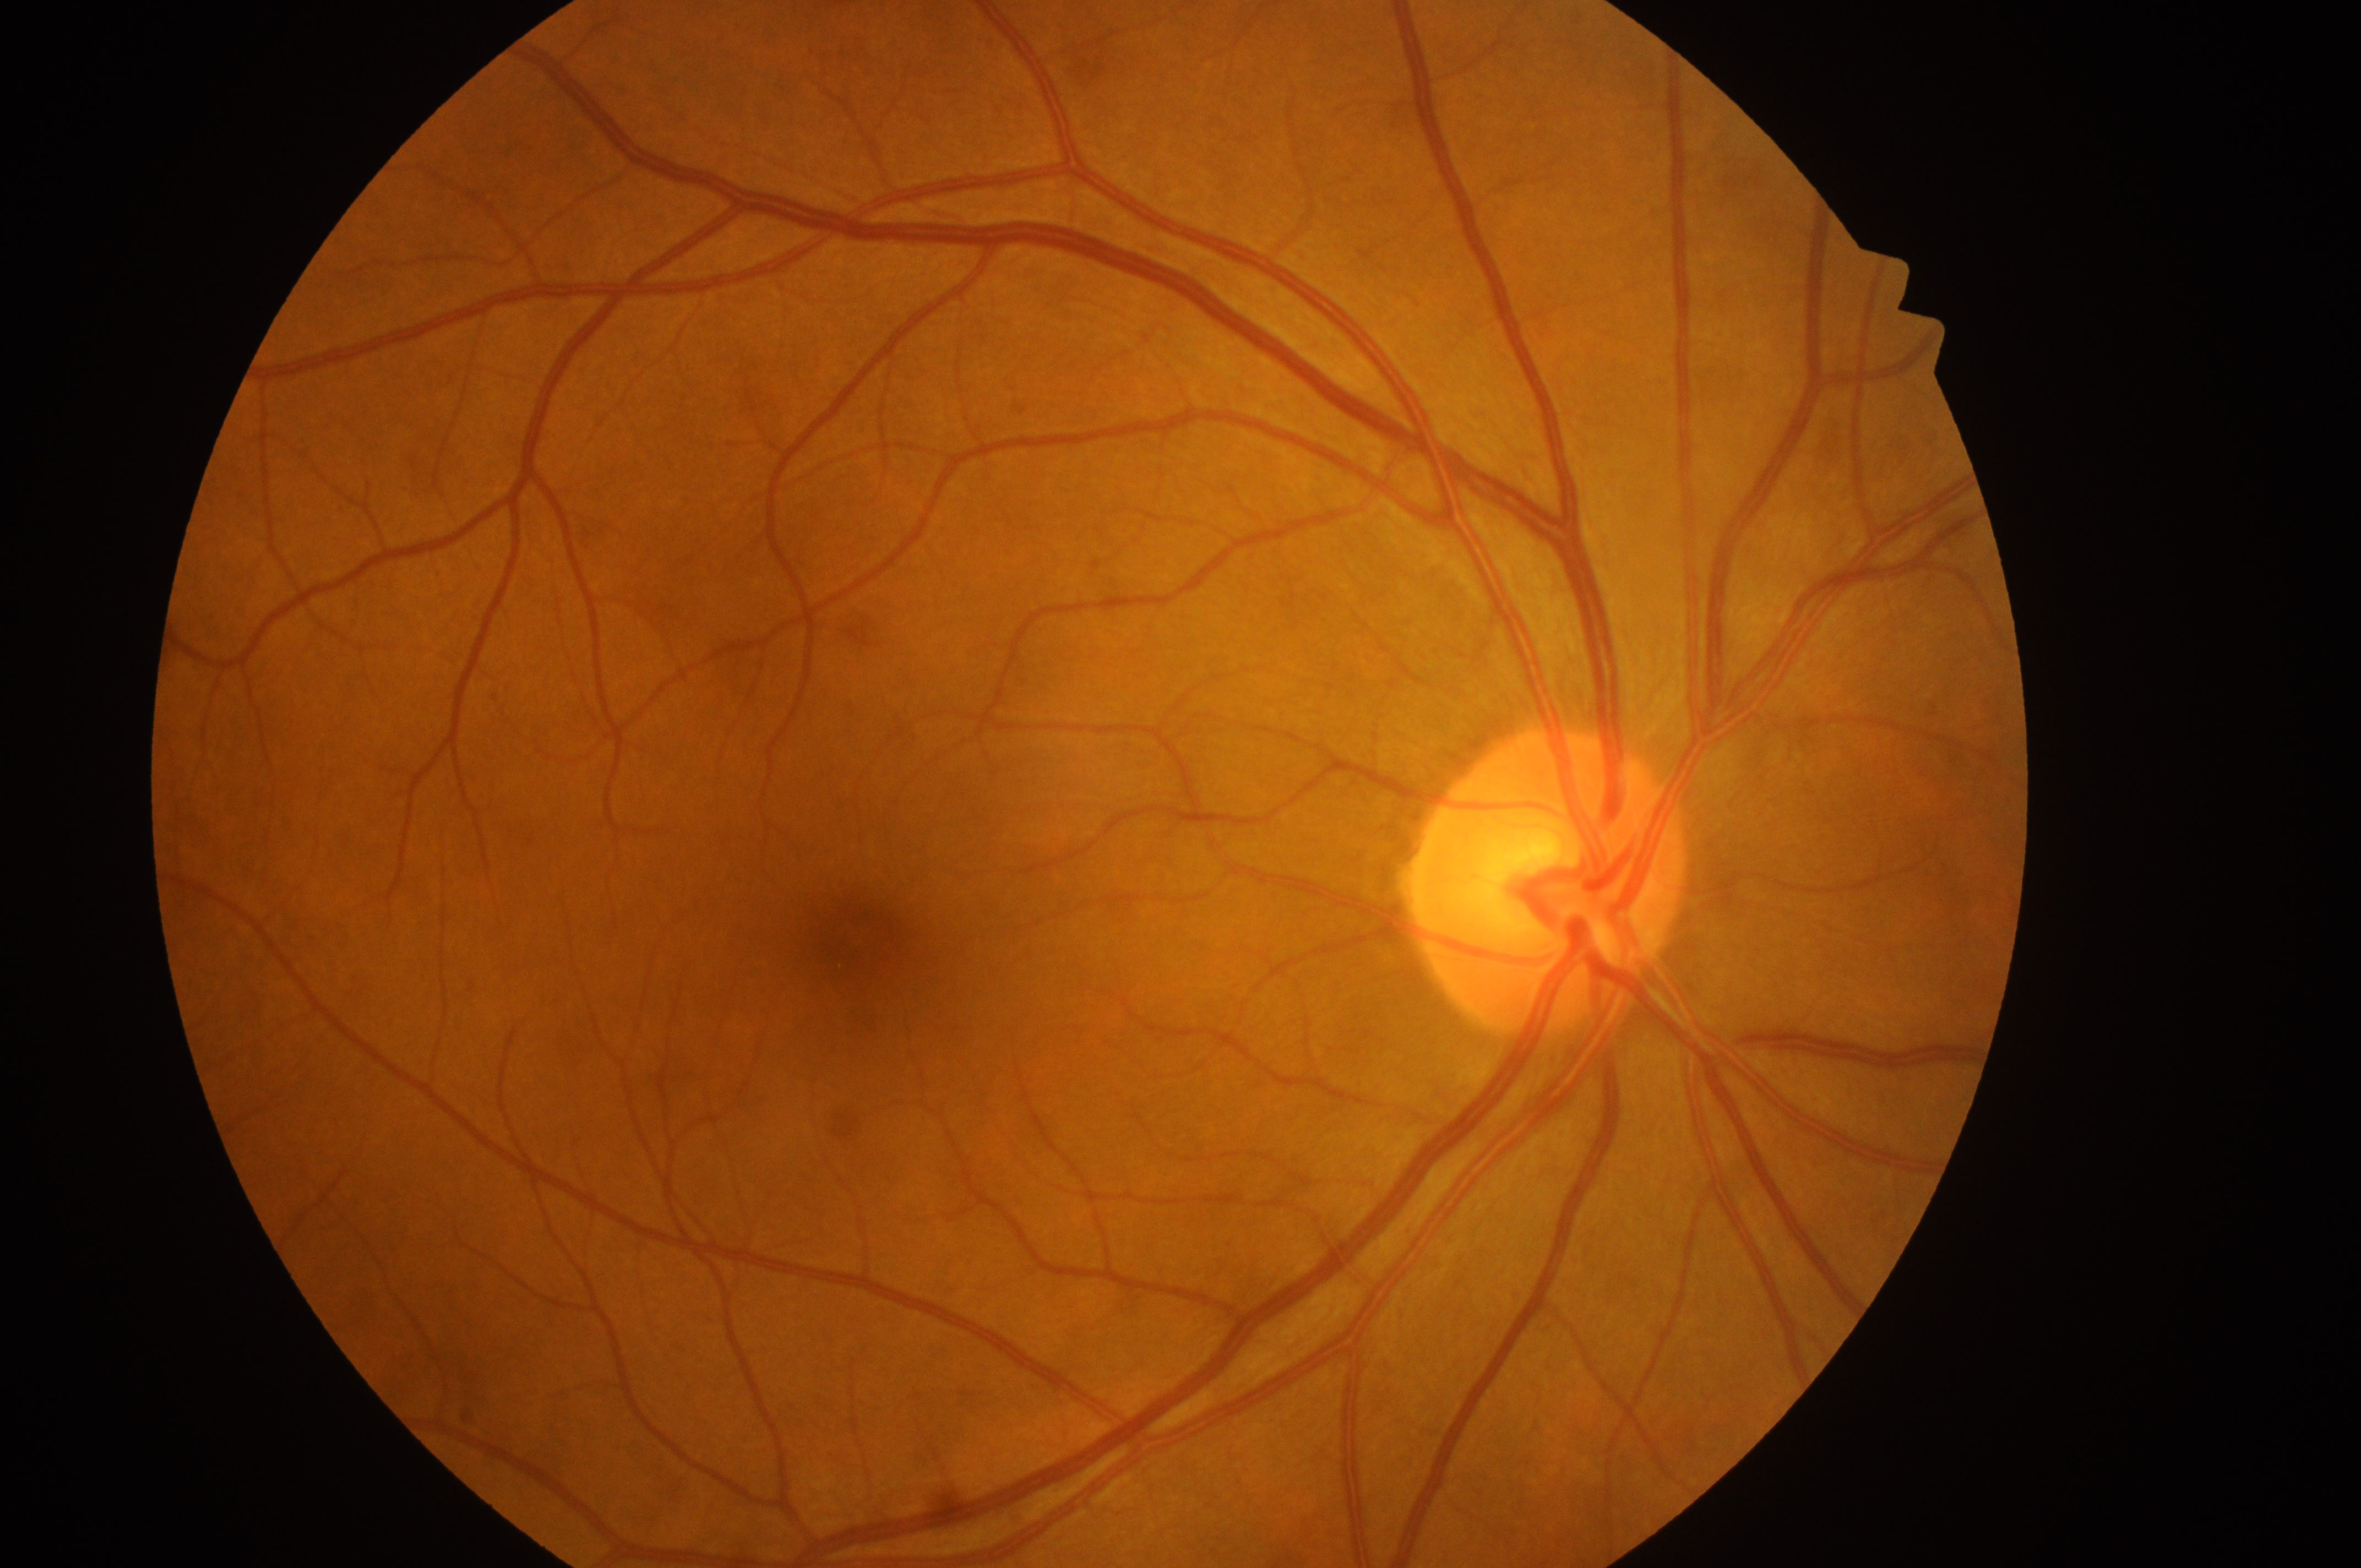 Macula center located at 860, 944.
Retinopathy: 0.
The image shows the OD.
Optic disc center: 1545, 903.
Macular edema is 0.